Color fundus image; 45° FOV; 2352 x 1568 pixels — 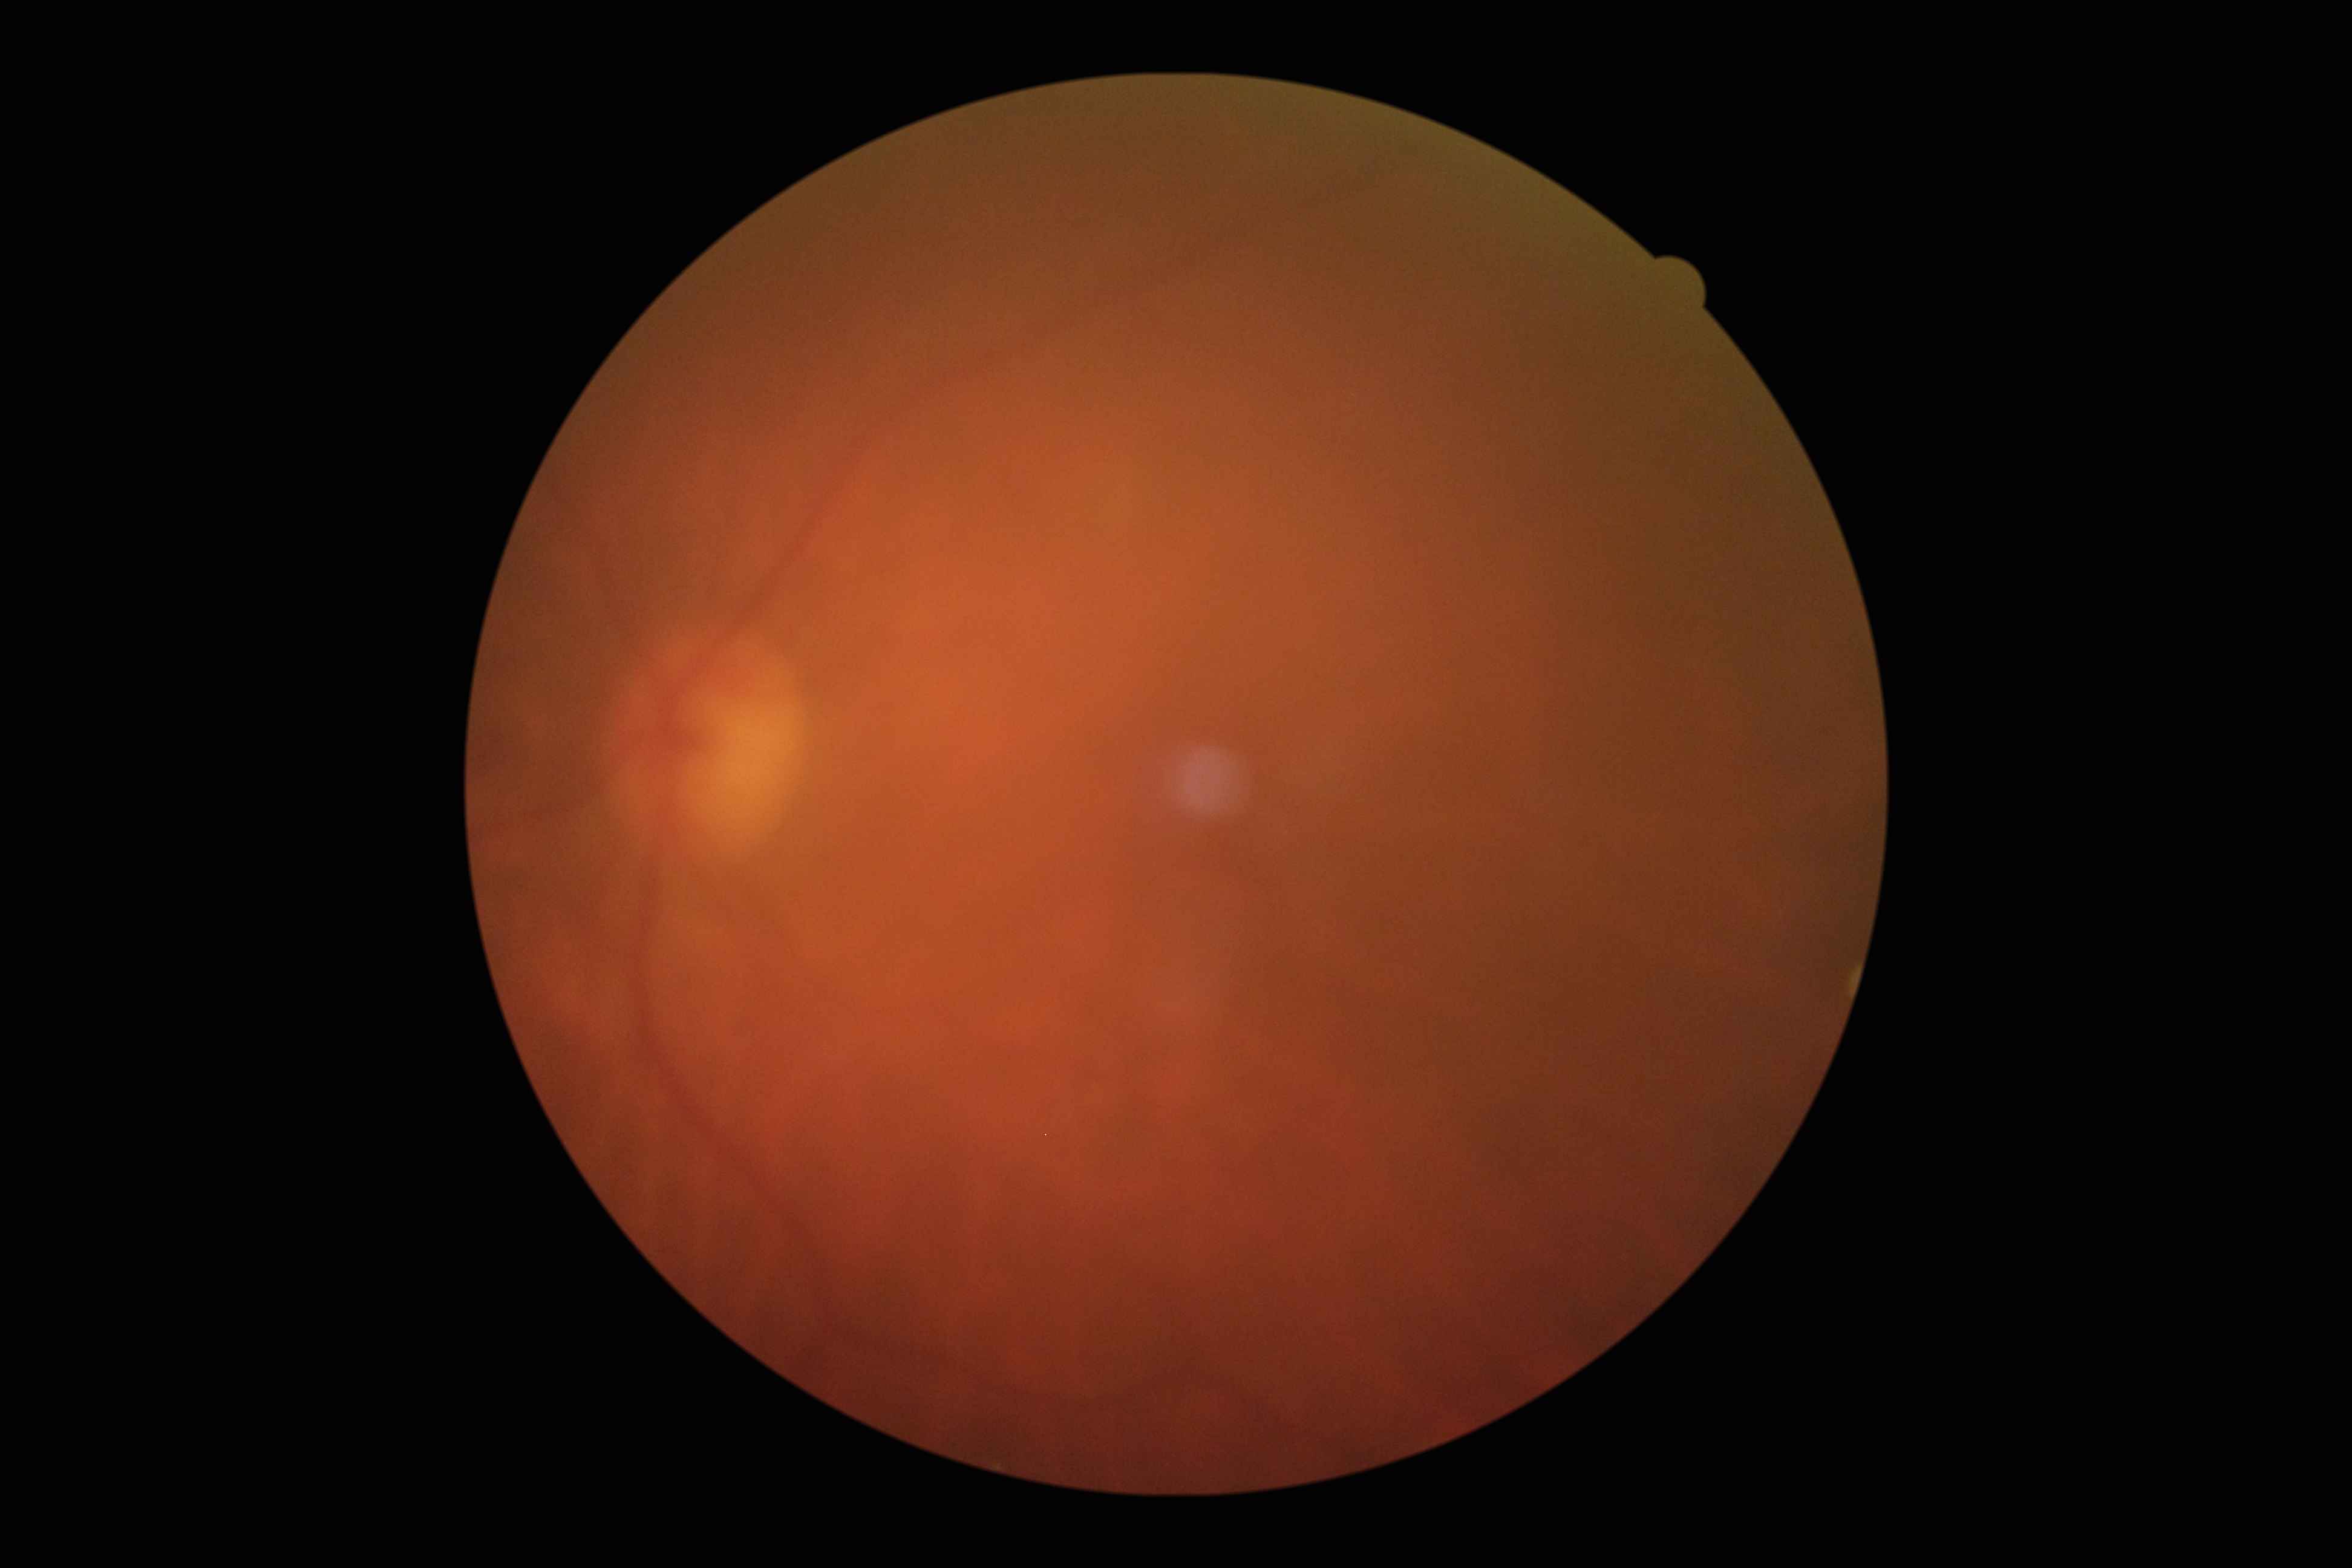
Diabetic retinopathy (DR) is ungradable due to poor image quality. Image quality is insufficient for diabetic retinopathy assessment.